Fundus photo.
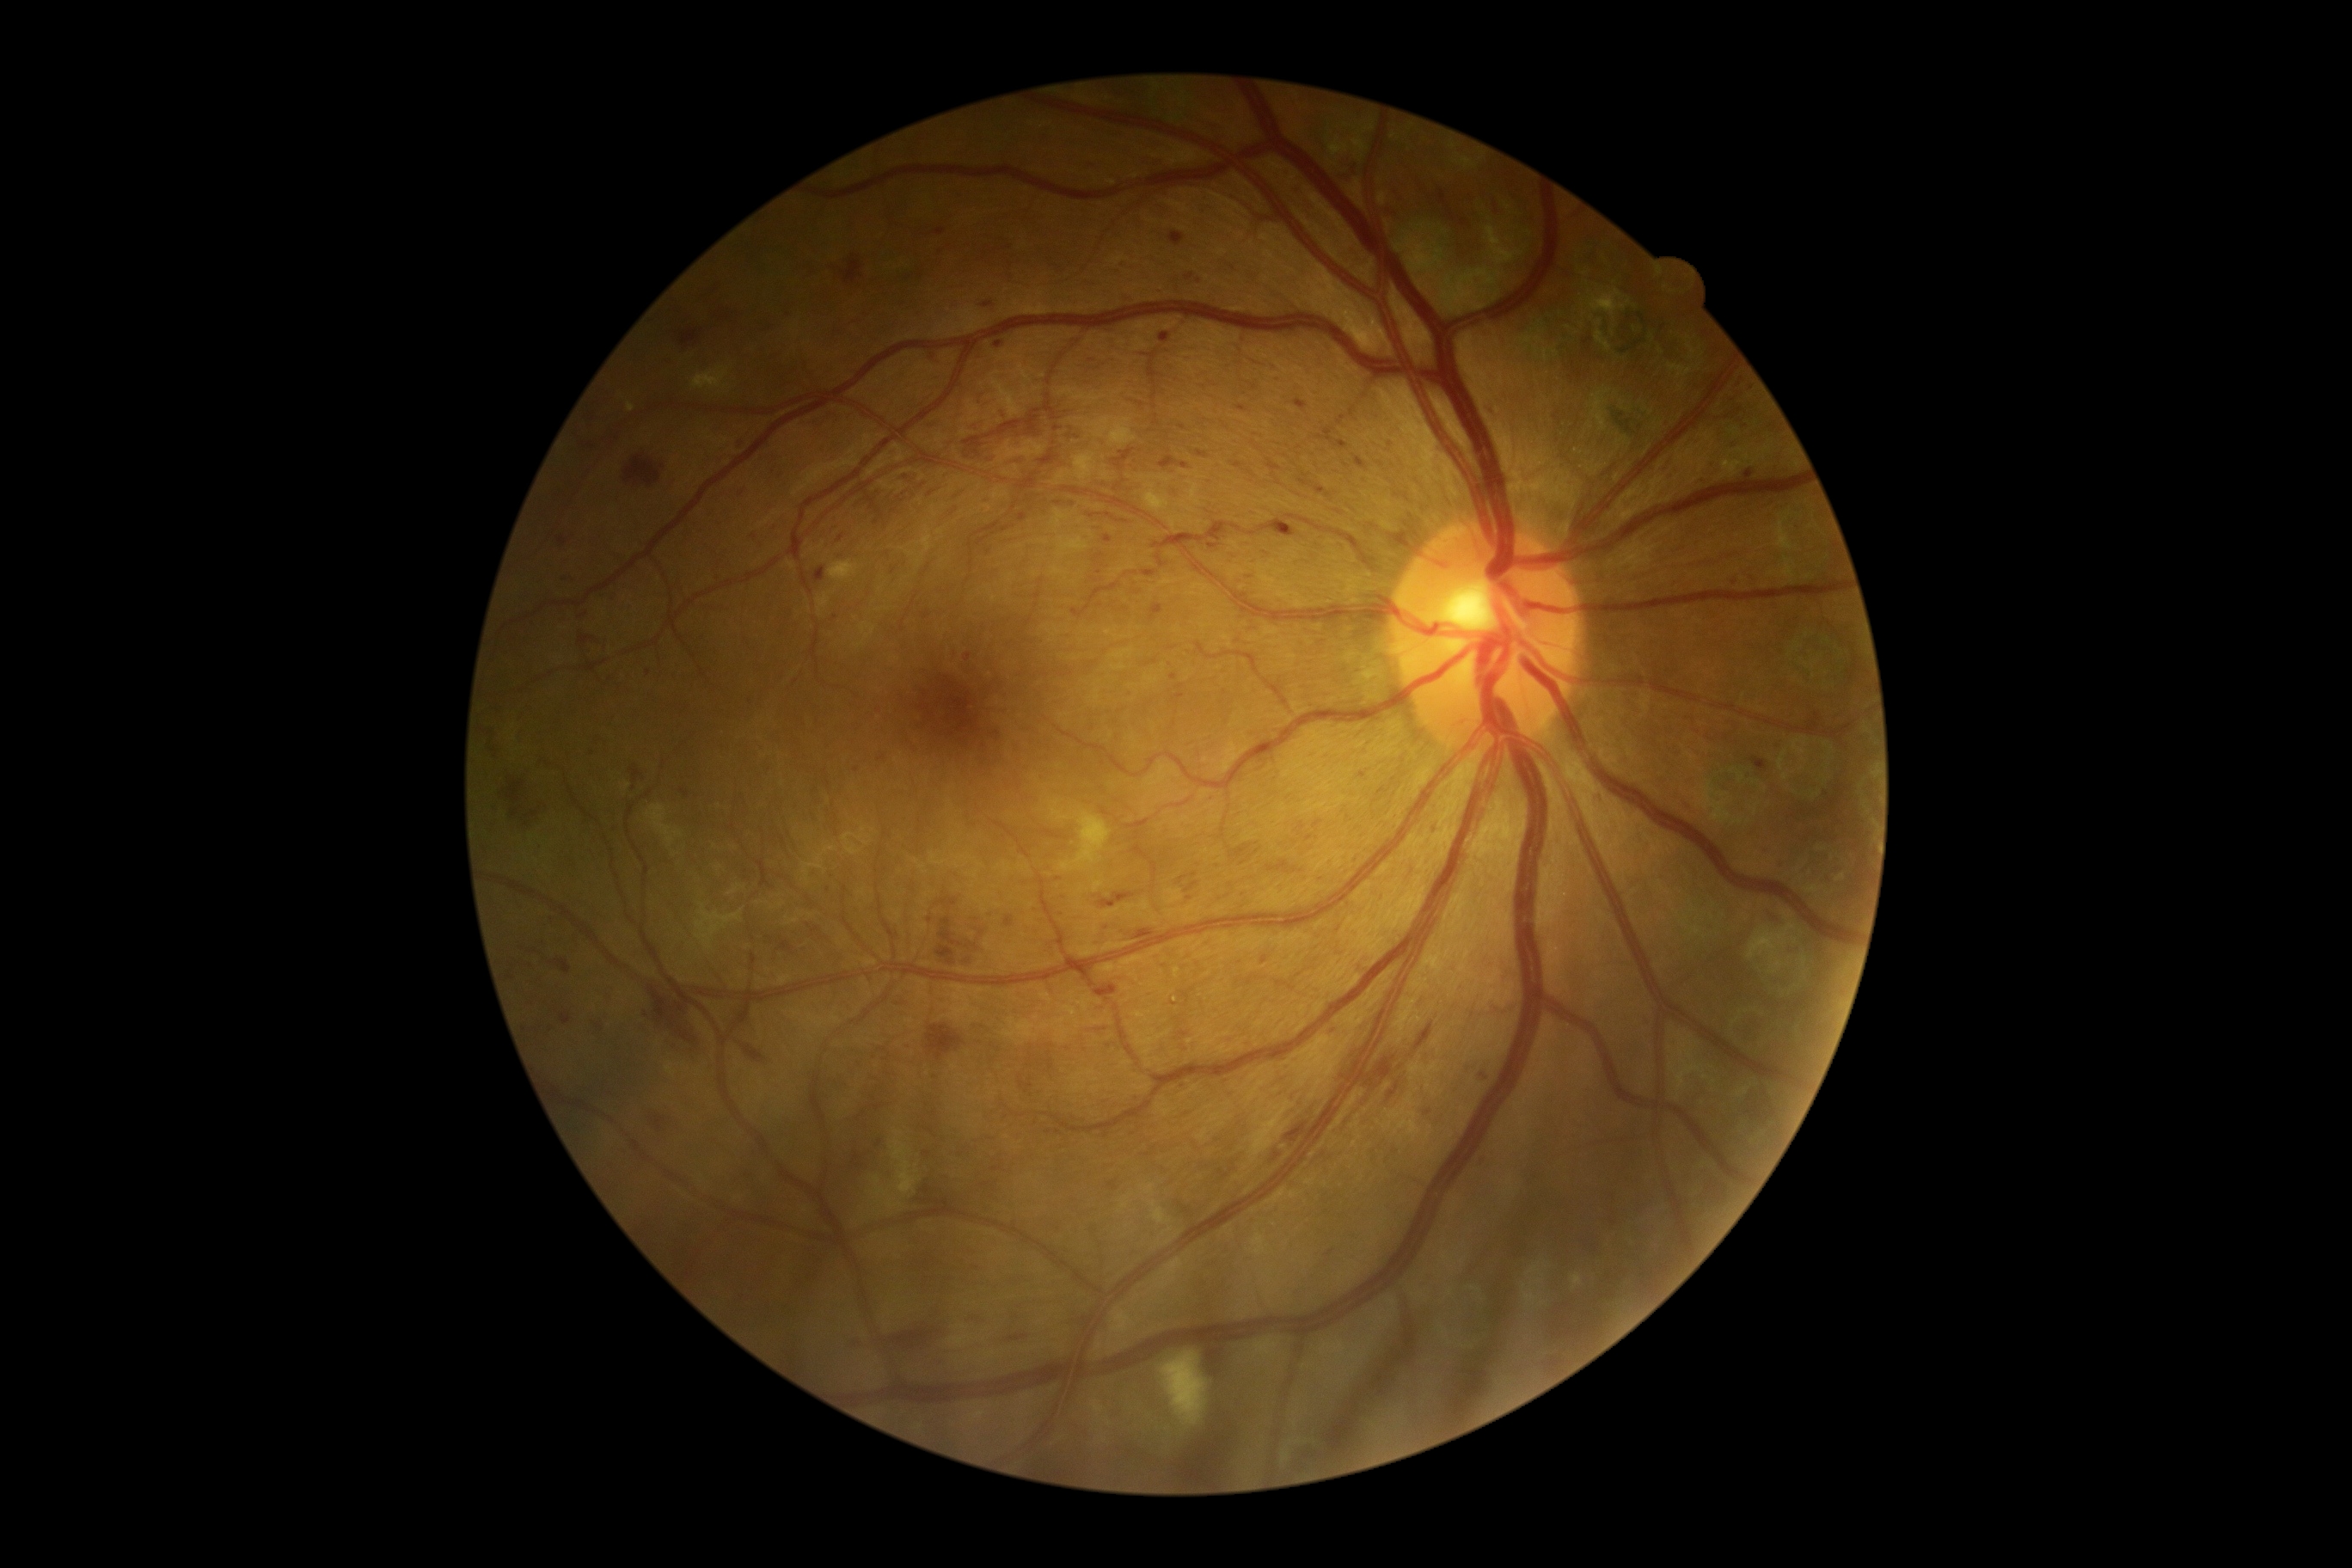
{"dr_grade": "3 (severe NPDR)"}